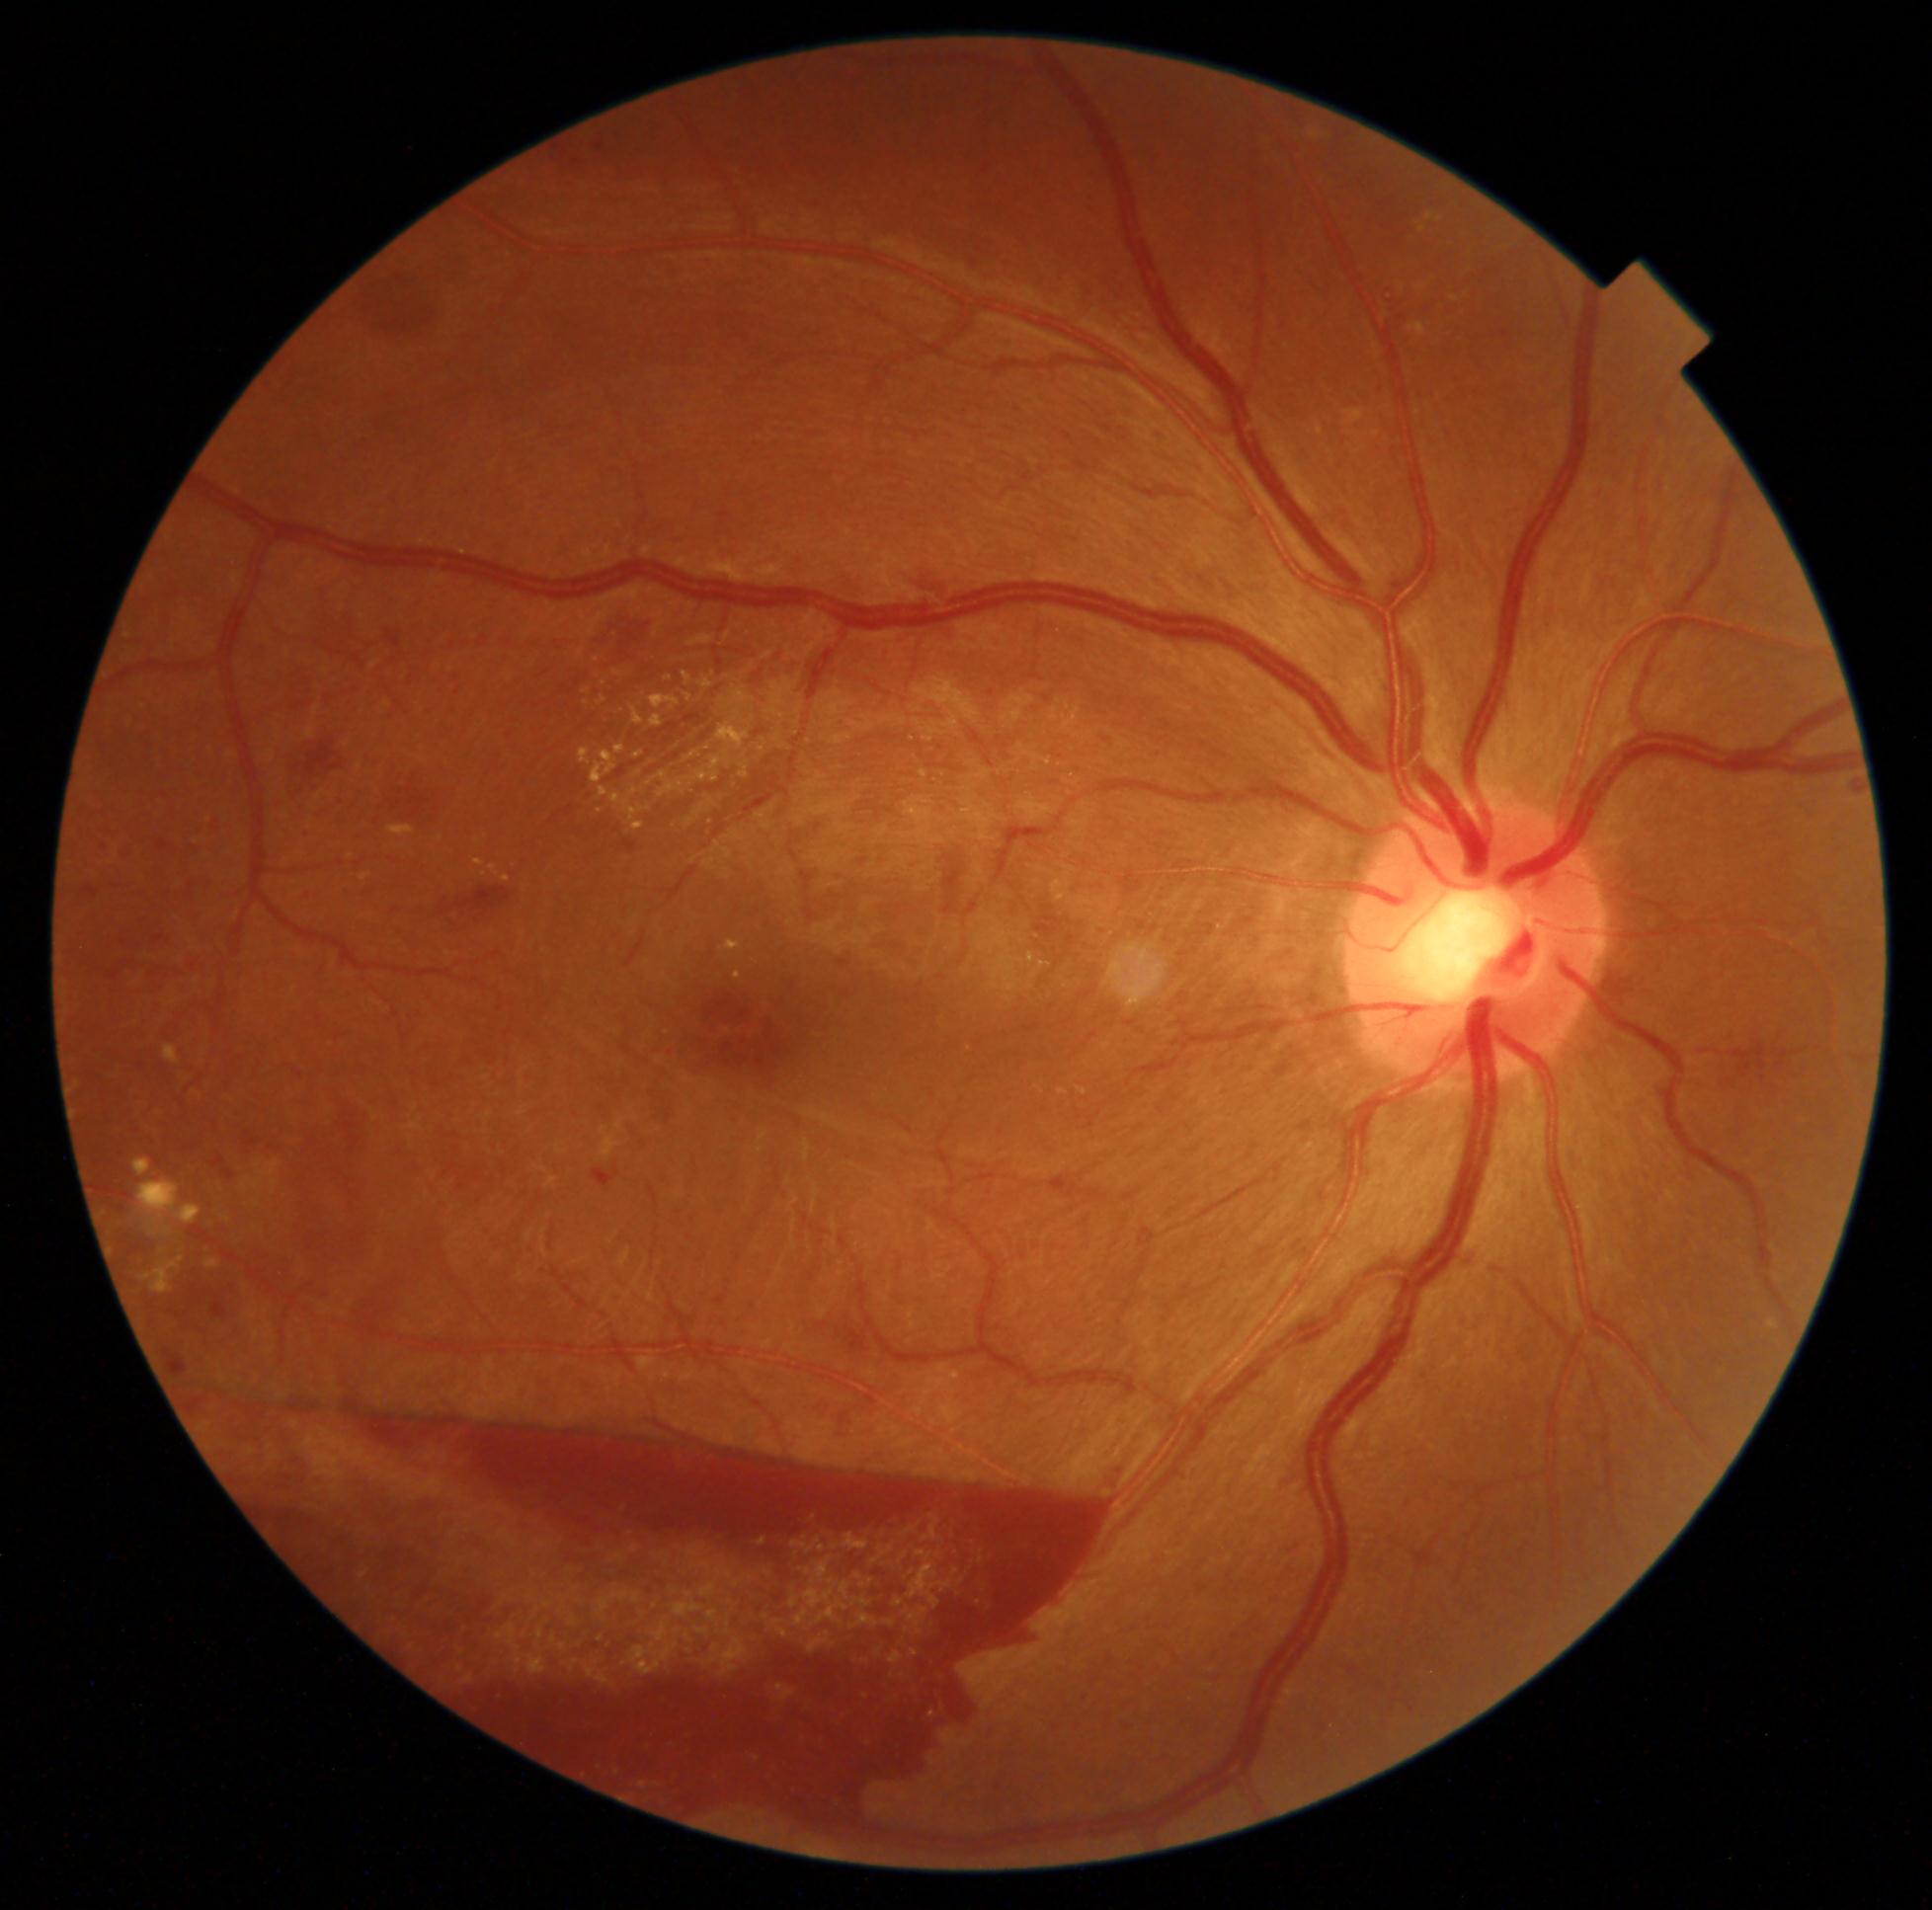

Diabetic retinopathy grade: 4.